45° field of view, nonmydriatic fundus photograph, 848x848
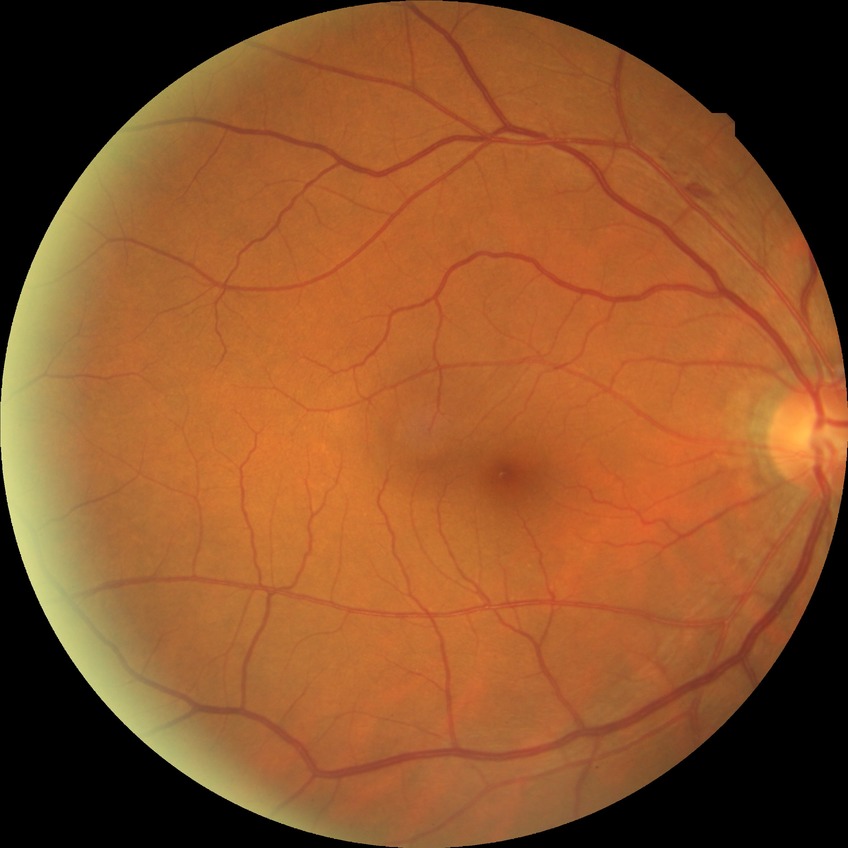

Diabetic retinopathy (DR): simple diabetic retinopathy (SDR).